Optic disc photograph · image size 361x361 · 35° field of view before cropping
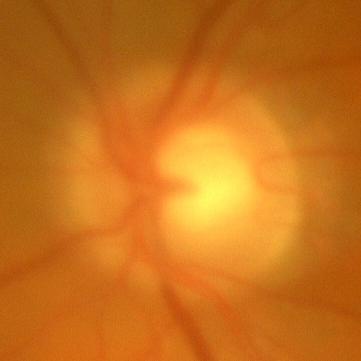
Consistent with no signs of glaucoma.